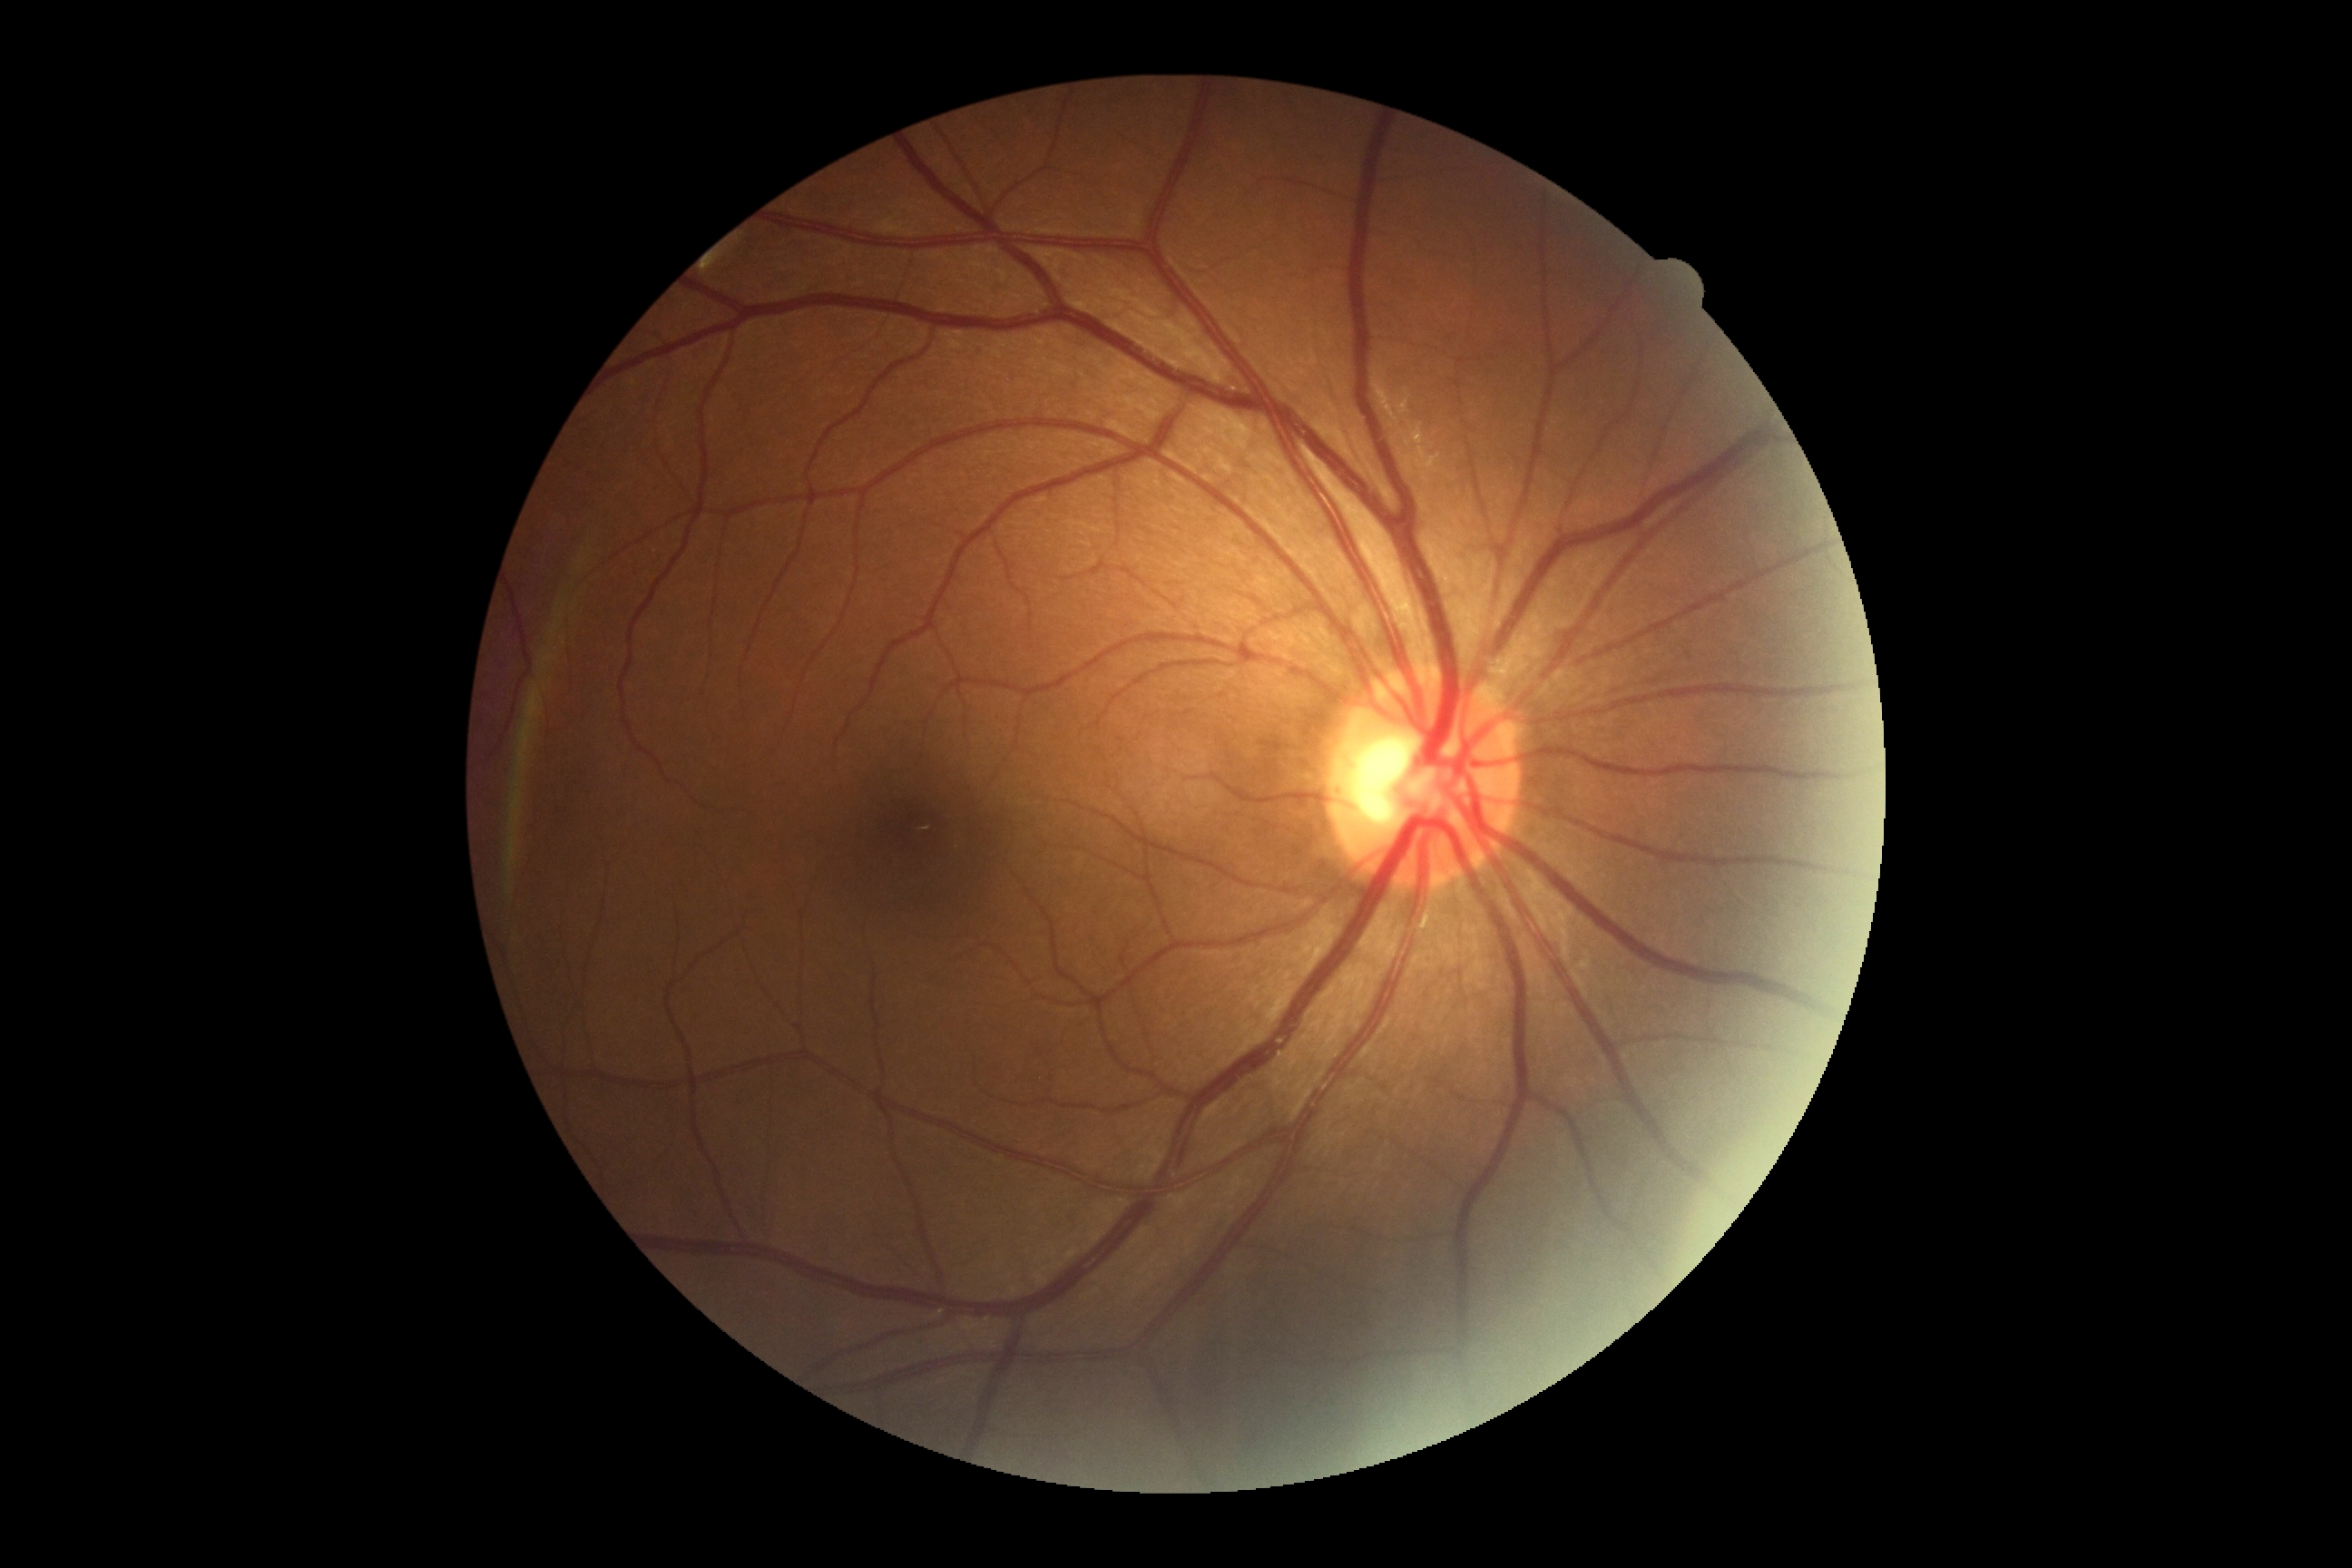 DR: grade 0 (no apparent retinopathy).